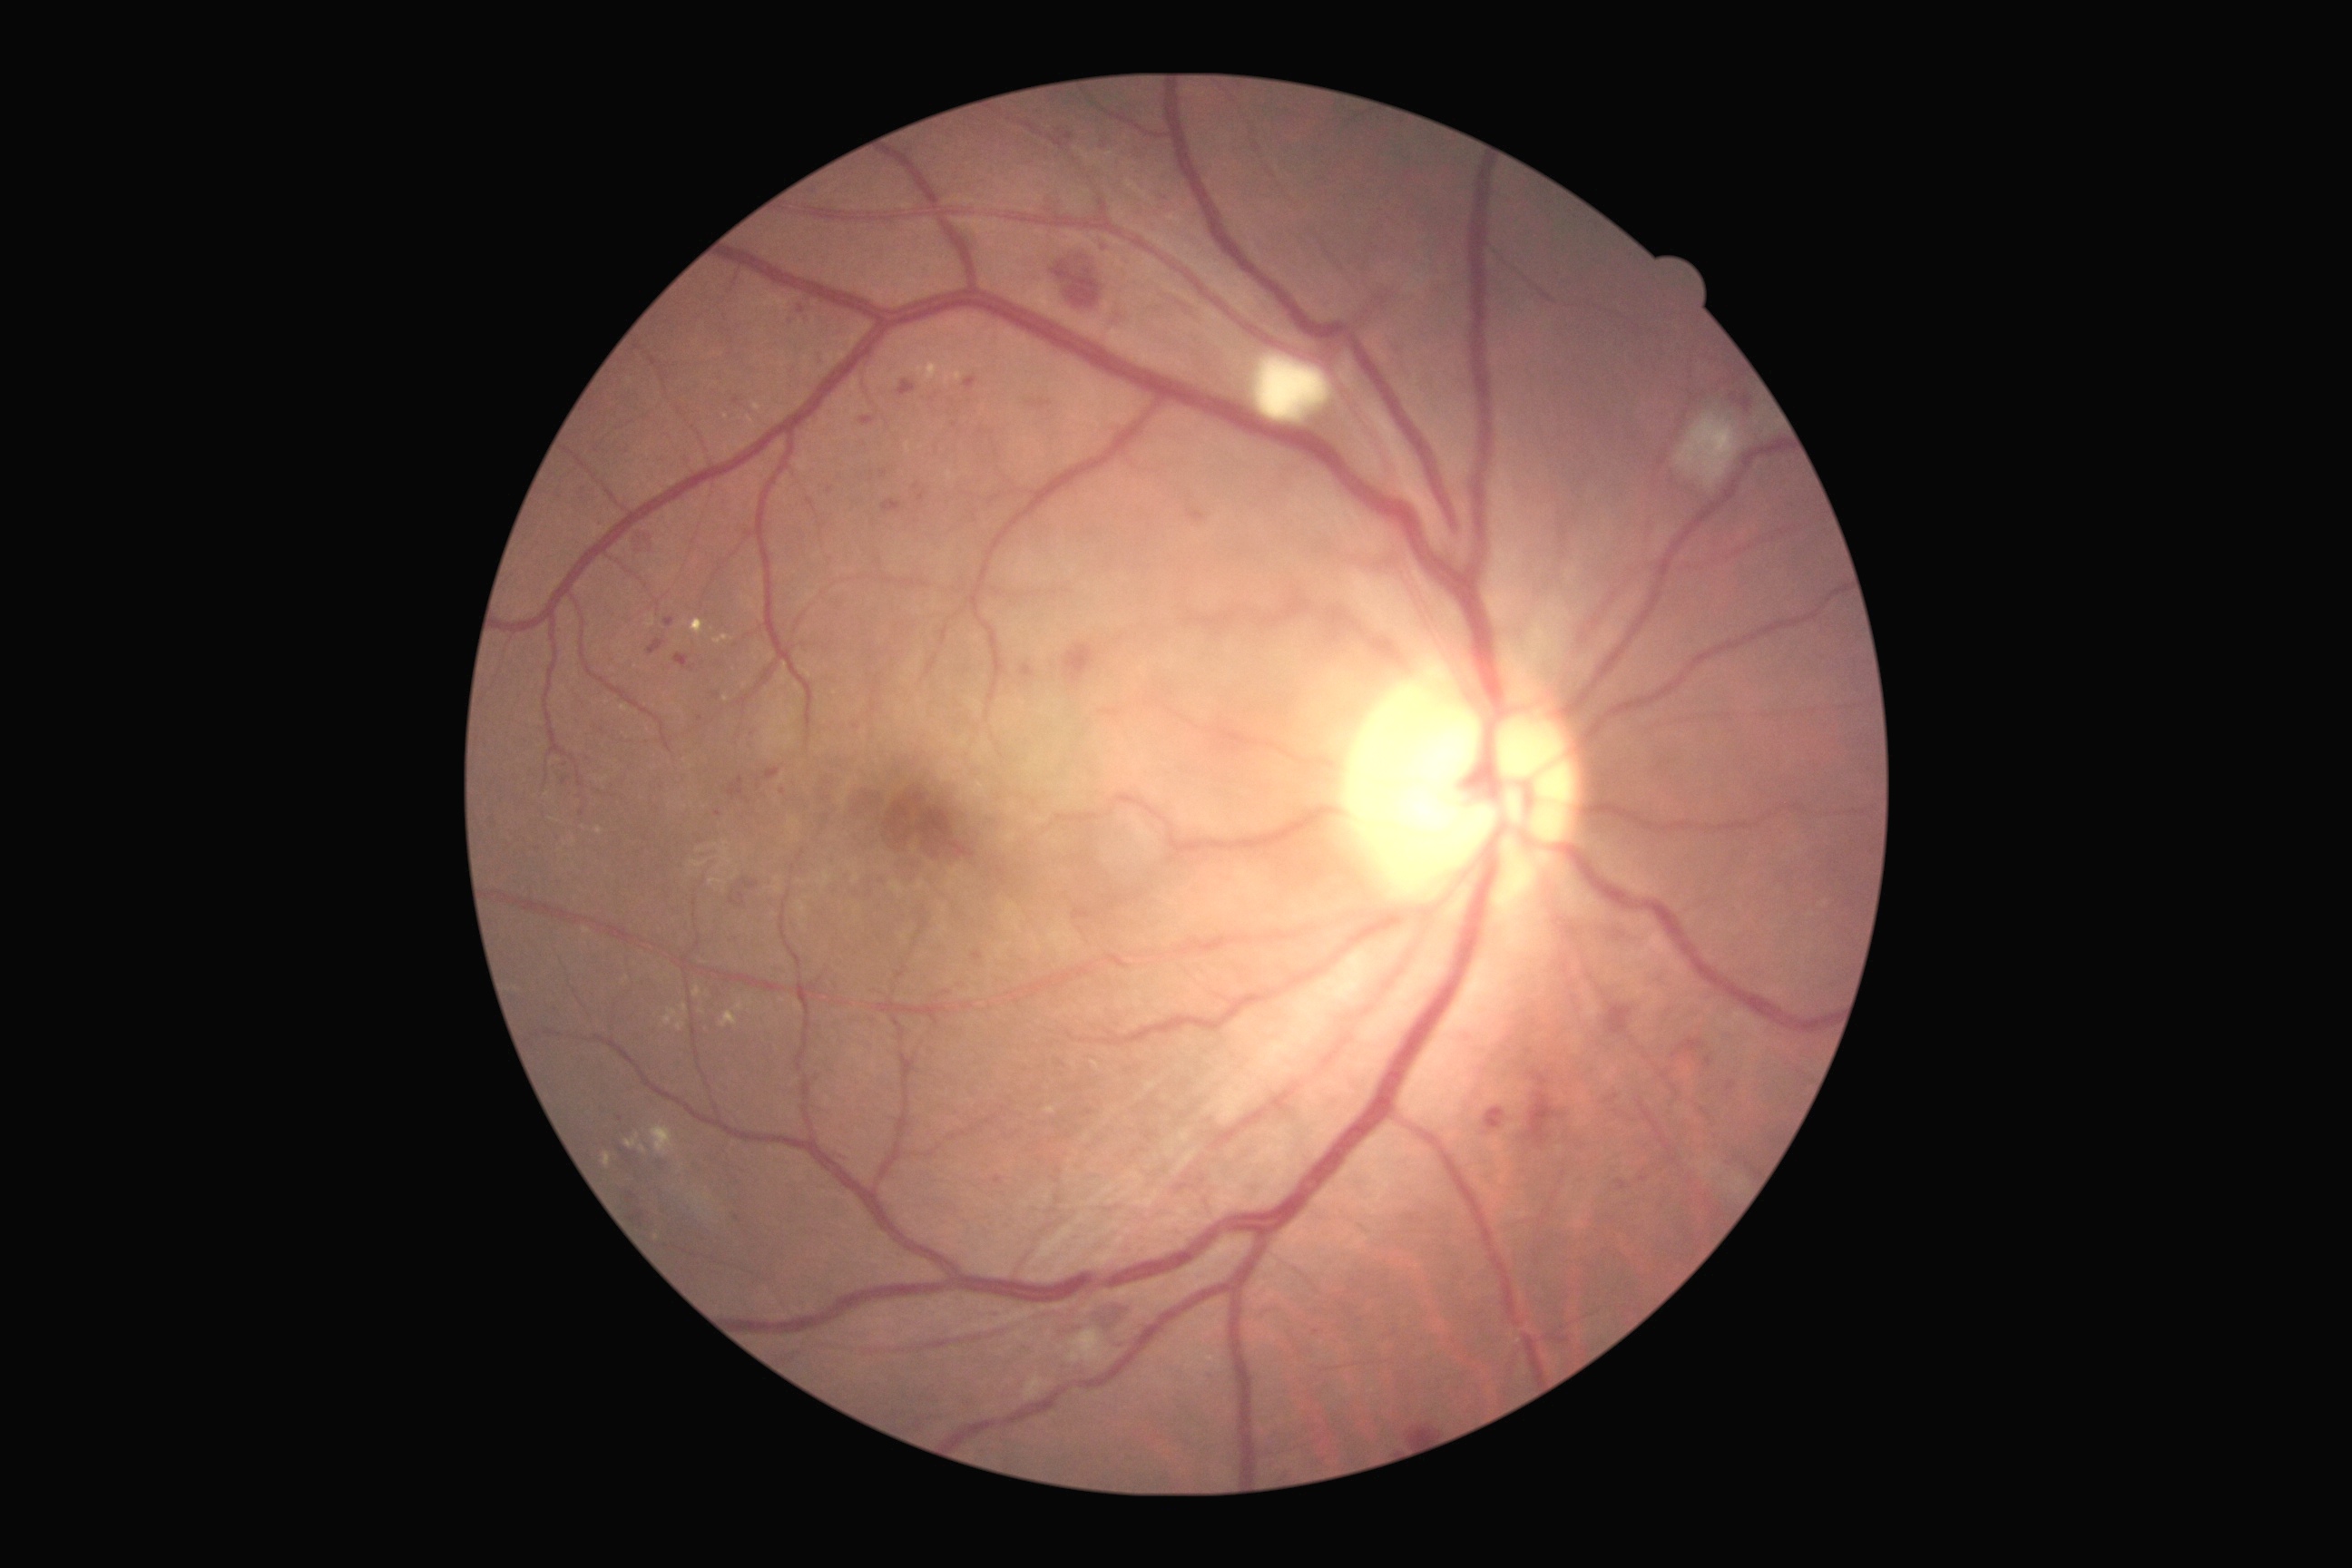

Retinopathy grade: 2.